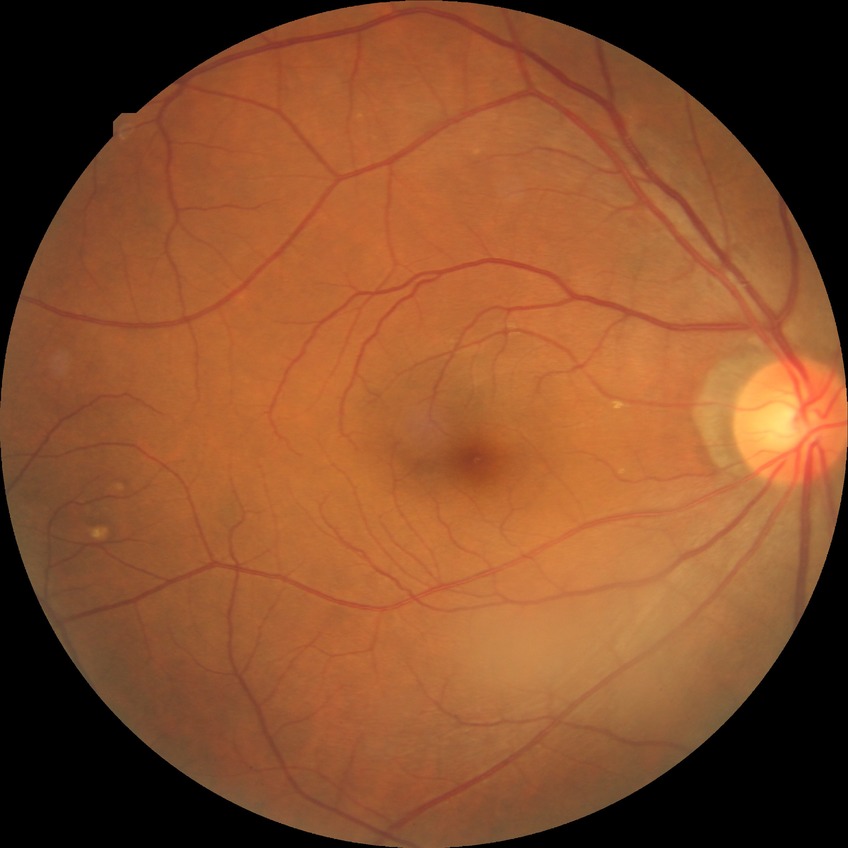 davis_grade: no diabetic retinopathy